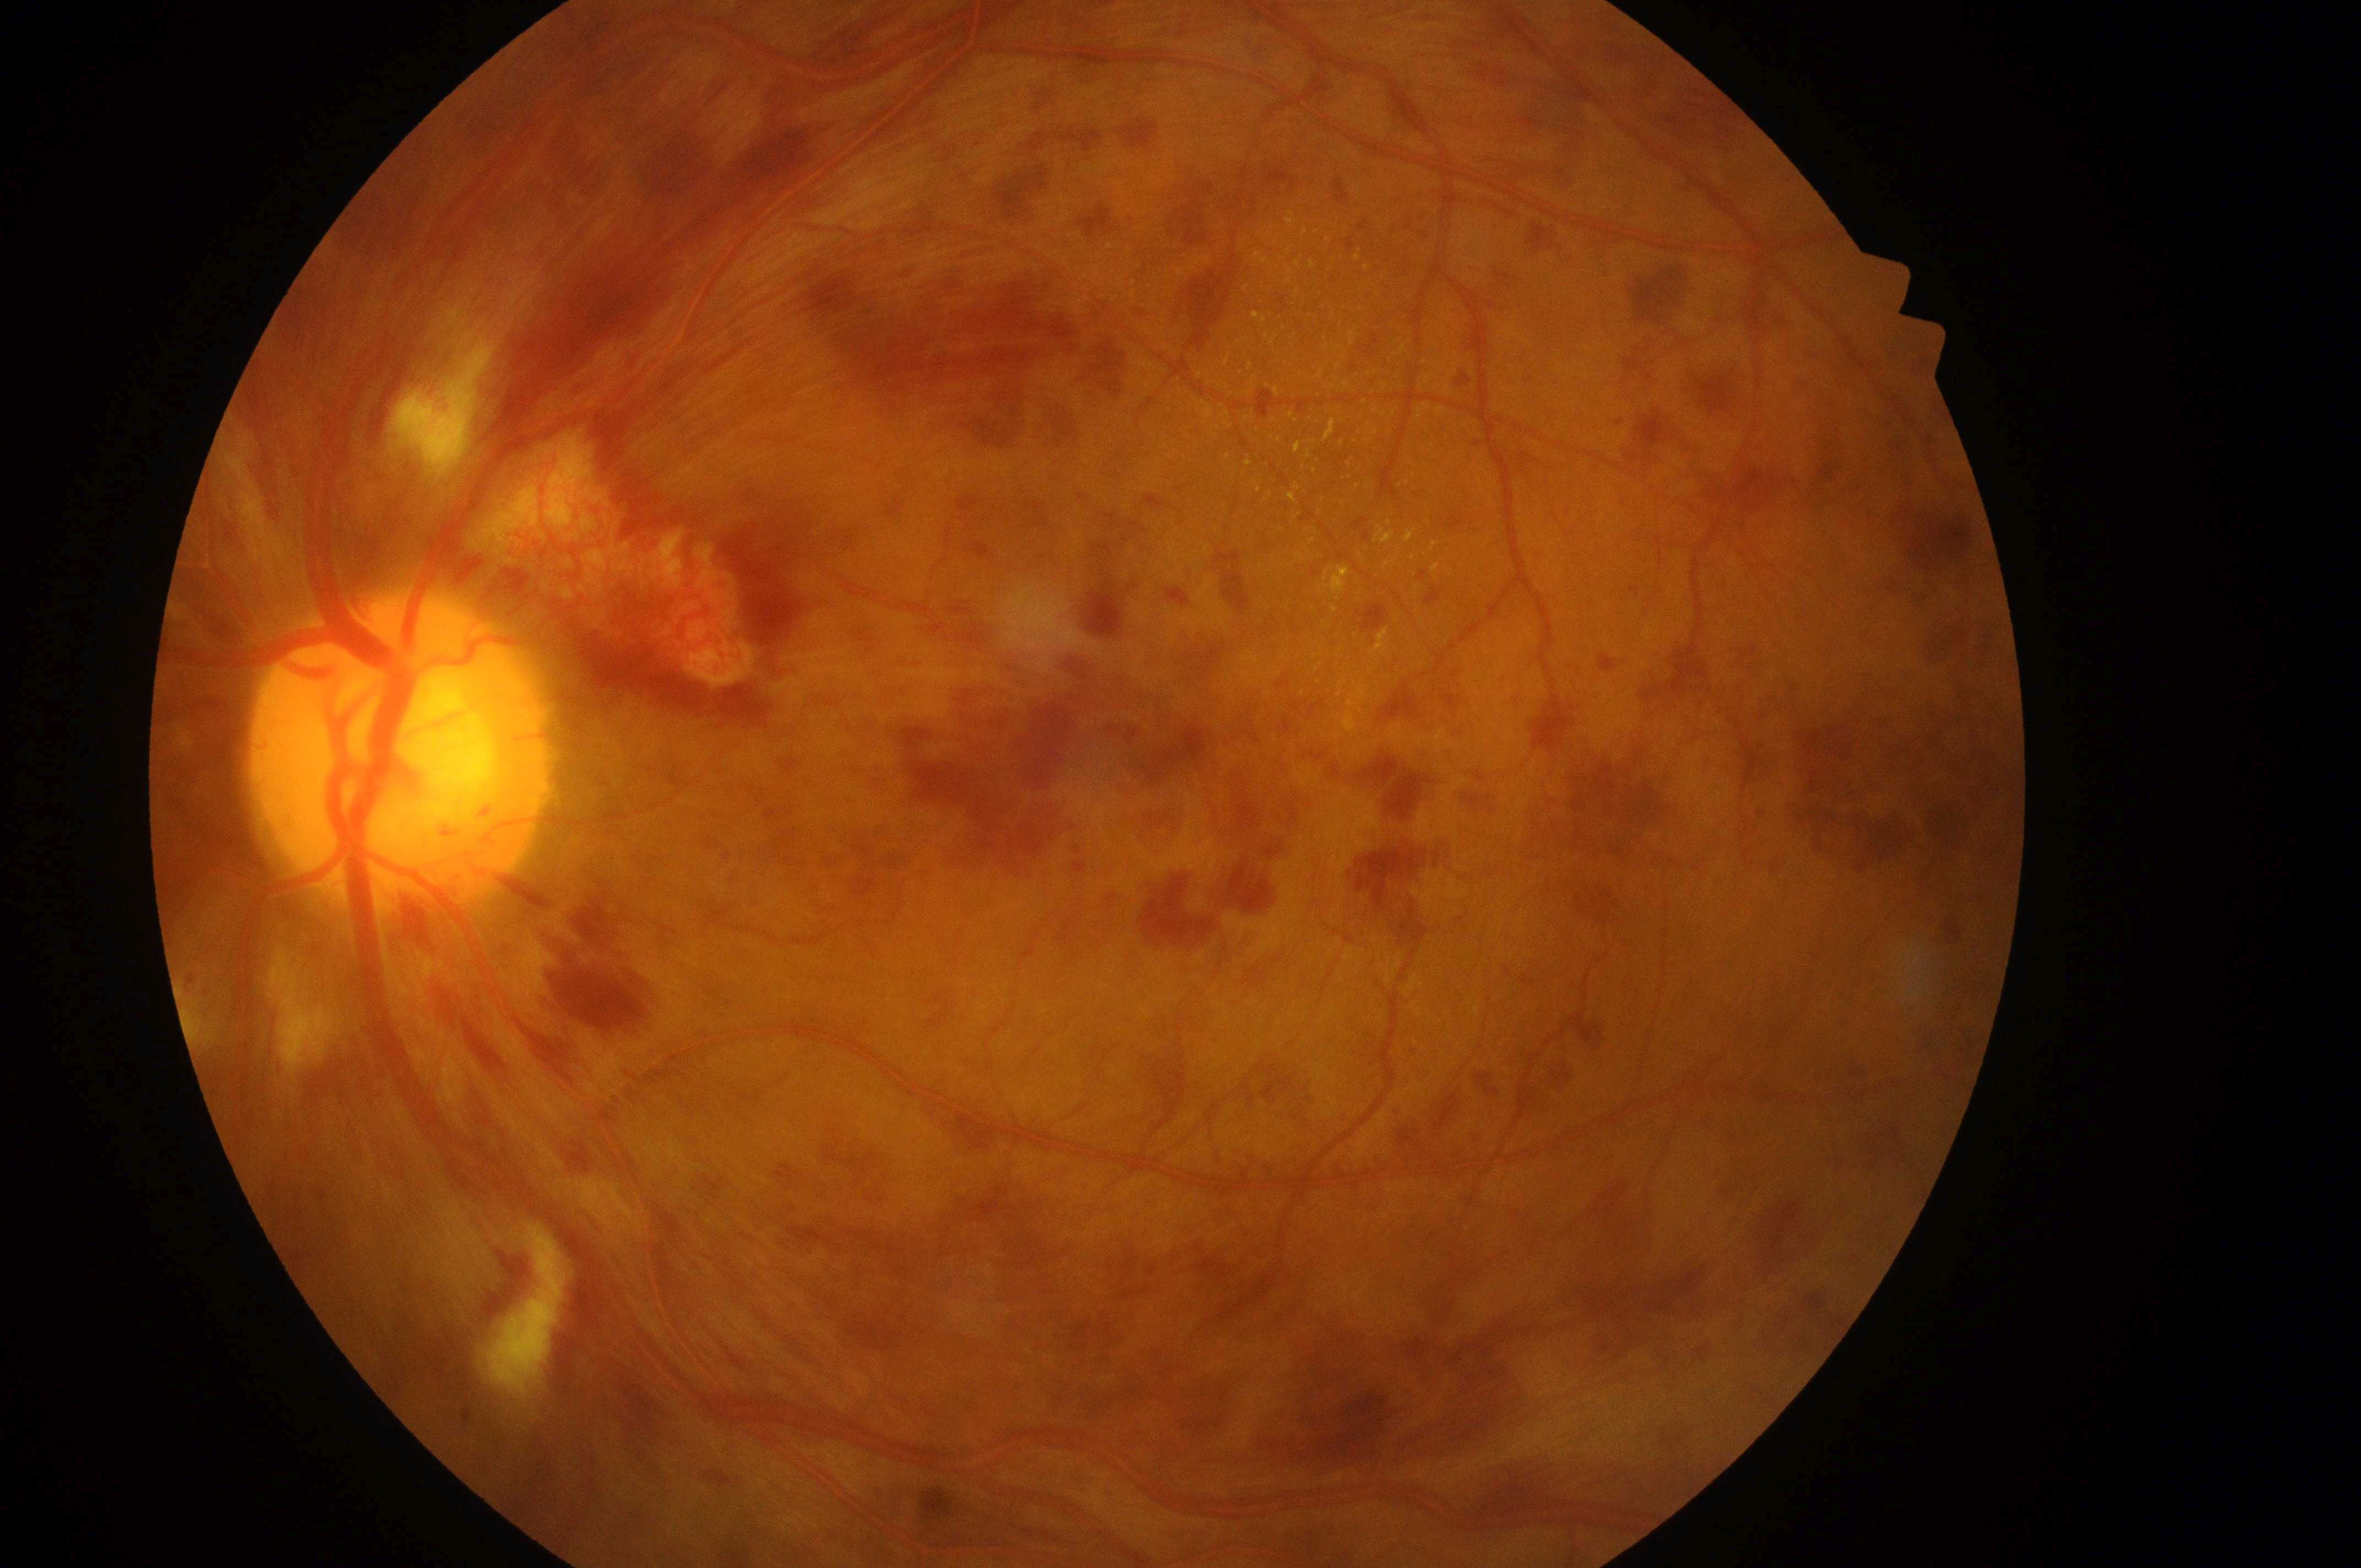
DME grade is high risk (2). The image shows the OS. The fovea is at (1107, 748). Optic disc: (396, 760). DR grade: proliferative diabetic retinopathy (4).